Fundus image cropped to the optic disc, image size 1006x1006, FOV 35° before cropping.
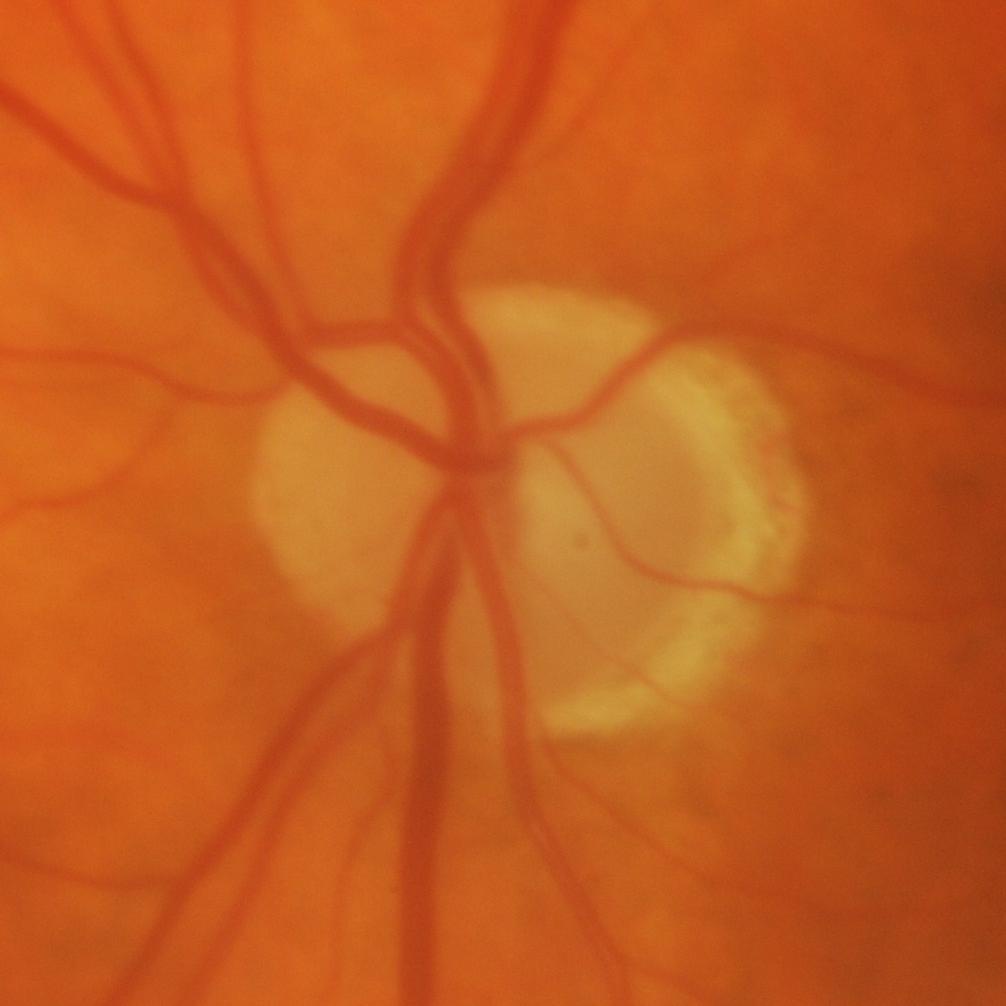
Showing glaucoma.